Without pupil dilation, 848 x 848 pixels, acquired with a NIDEK AFC-230, graded on the modified Davis scale — 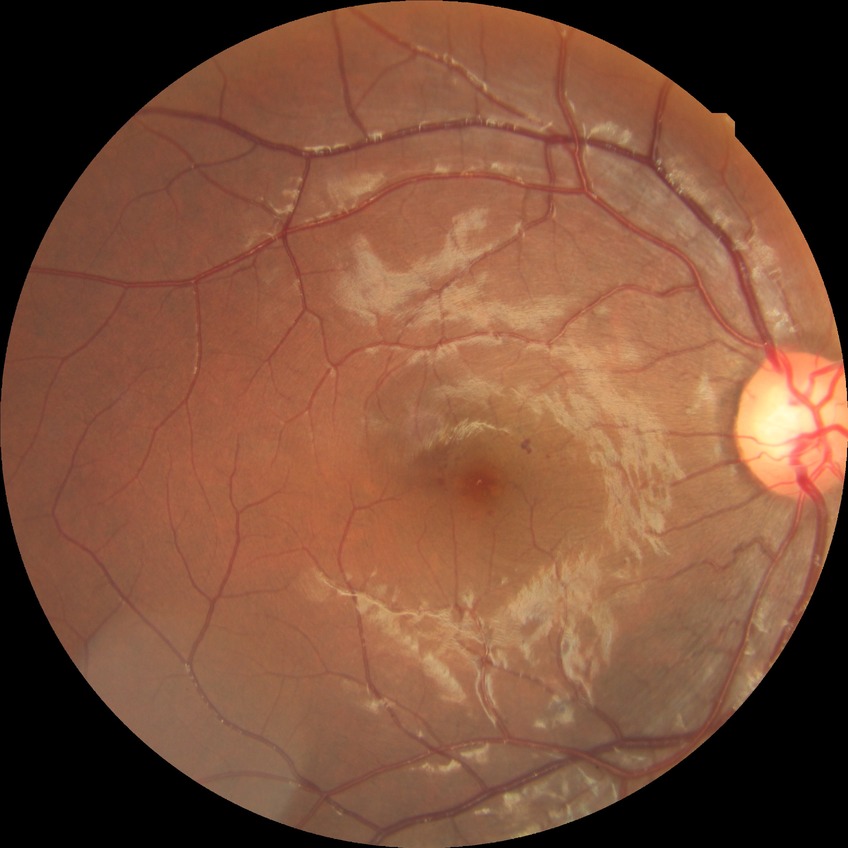 Diabetic retinopathy (DR): SDR (simple diabetic retinopathy).